848 x 848 pixels. No pharmacologic dilation.
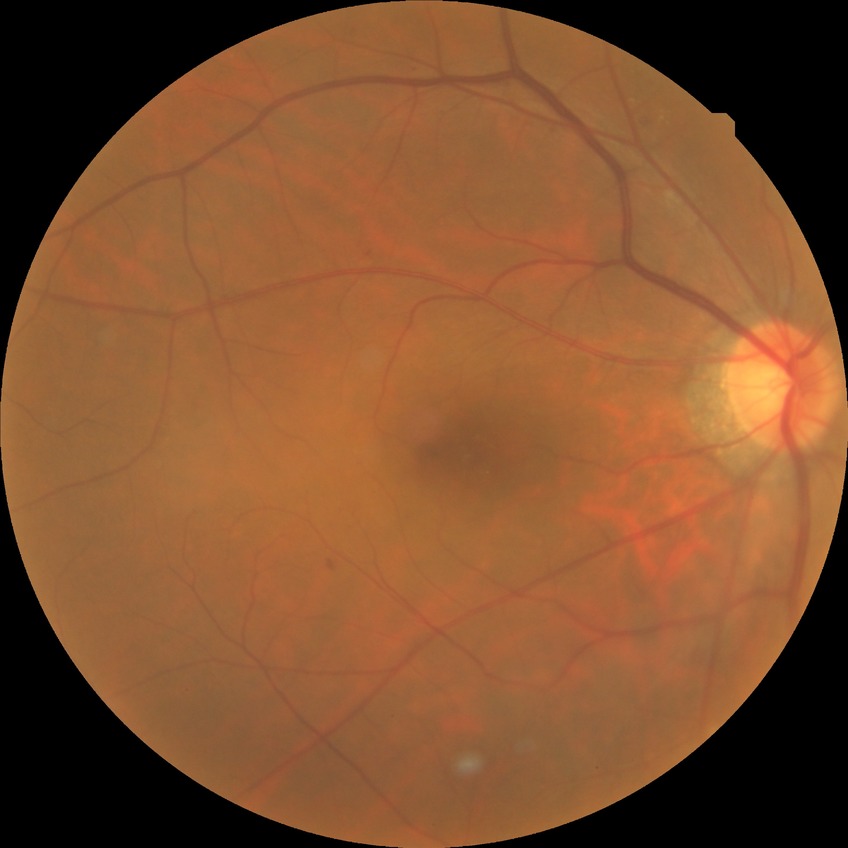 Diabetic retinopathy (DR): SDR (simple diabetic retinopathy).